No pharmacologic dilation; modified Davis classification; posterior pole color fundus photograph.
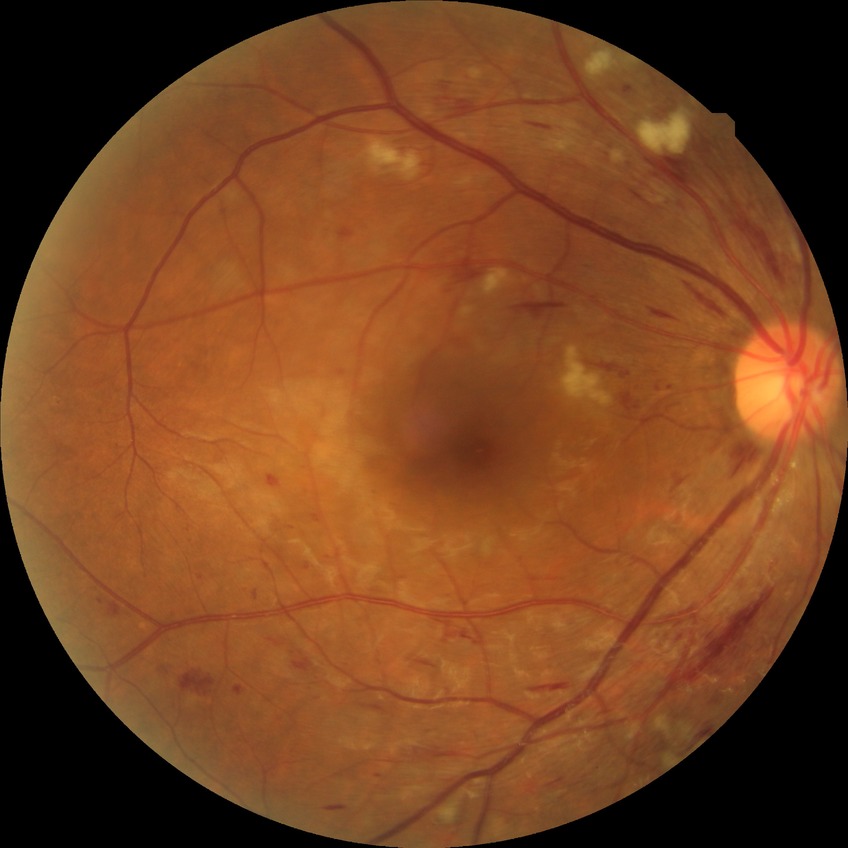 diabetic retinopathy (DR): pre-proliferative diabetic retinopathy (PPDR)